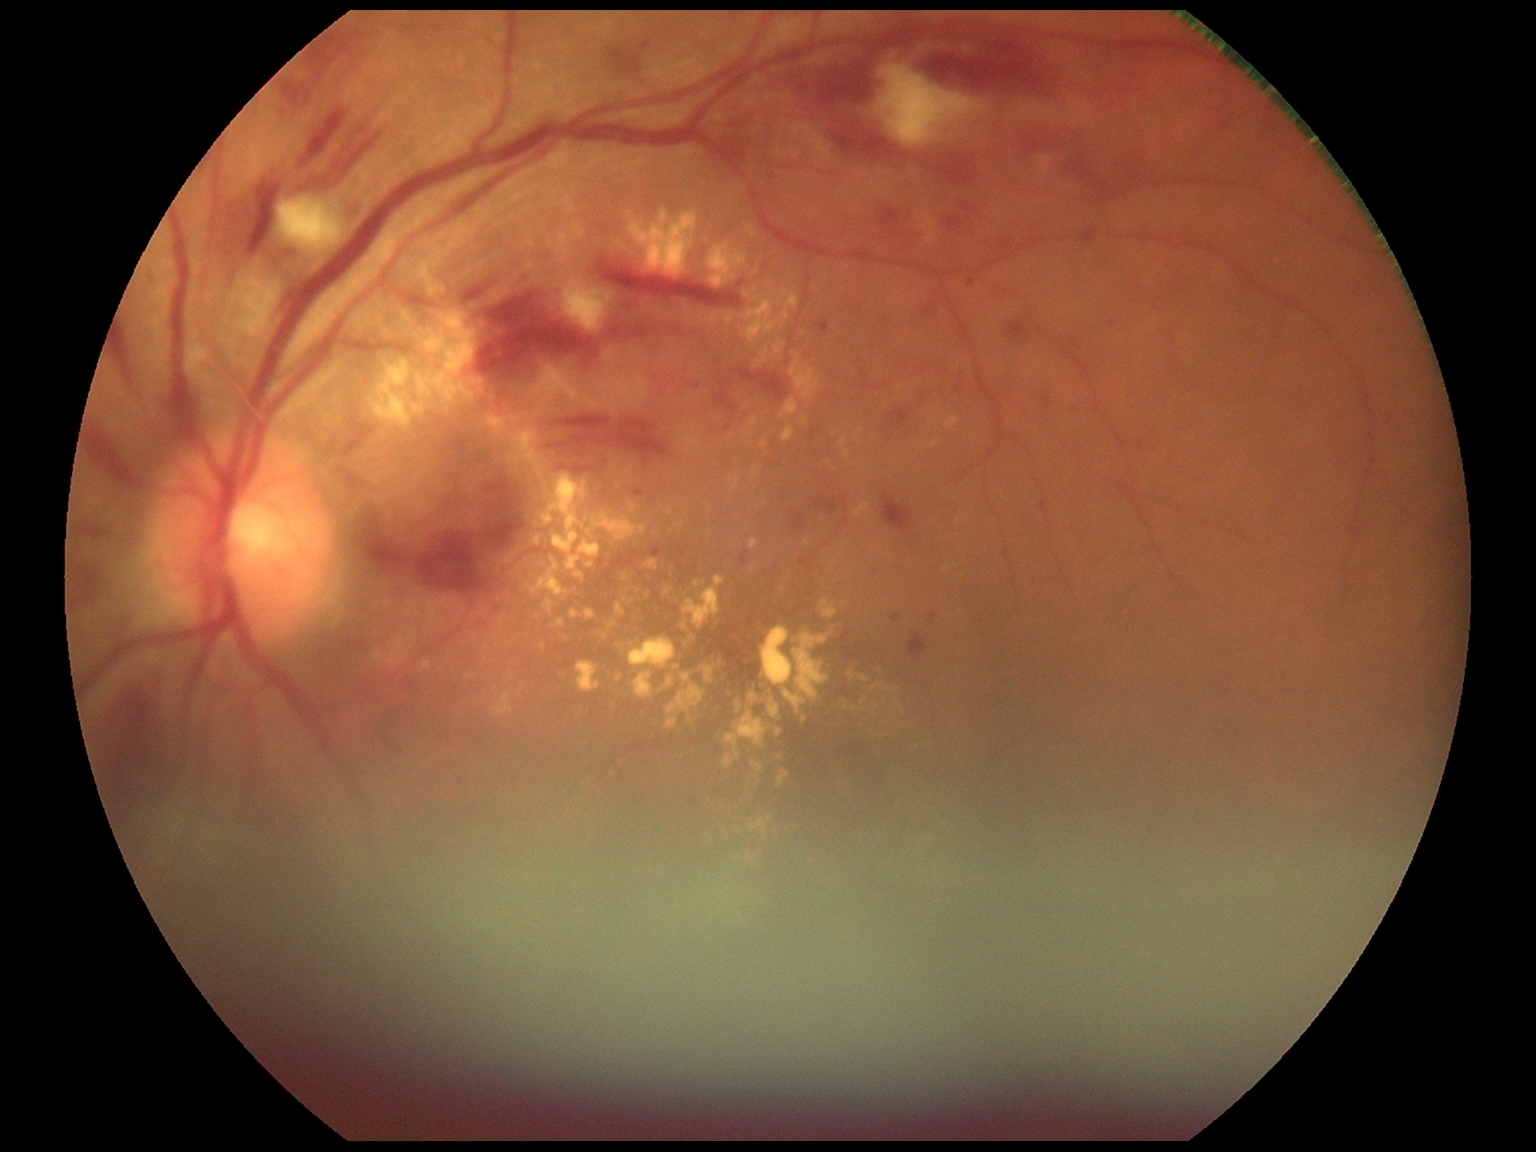

* DR: 2/4